45-degree field of view
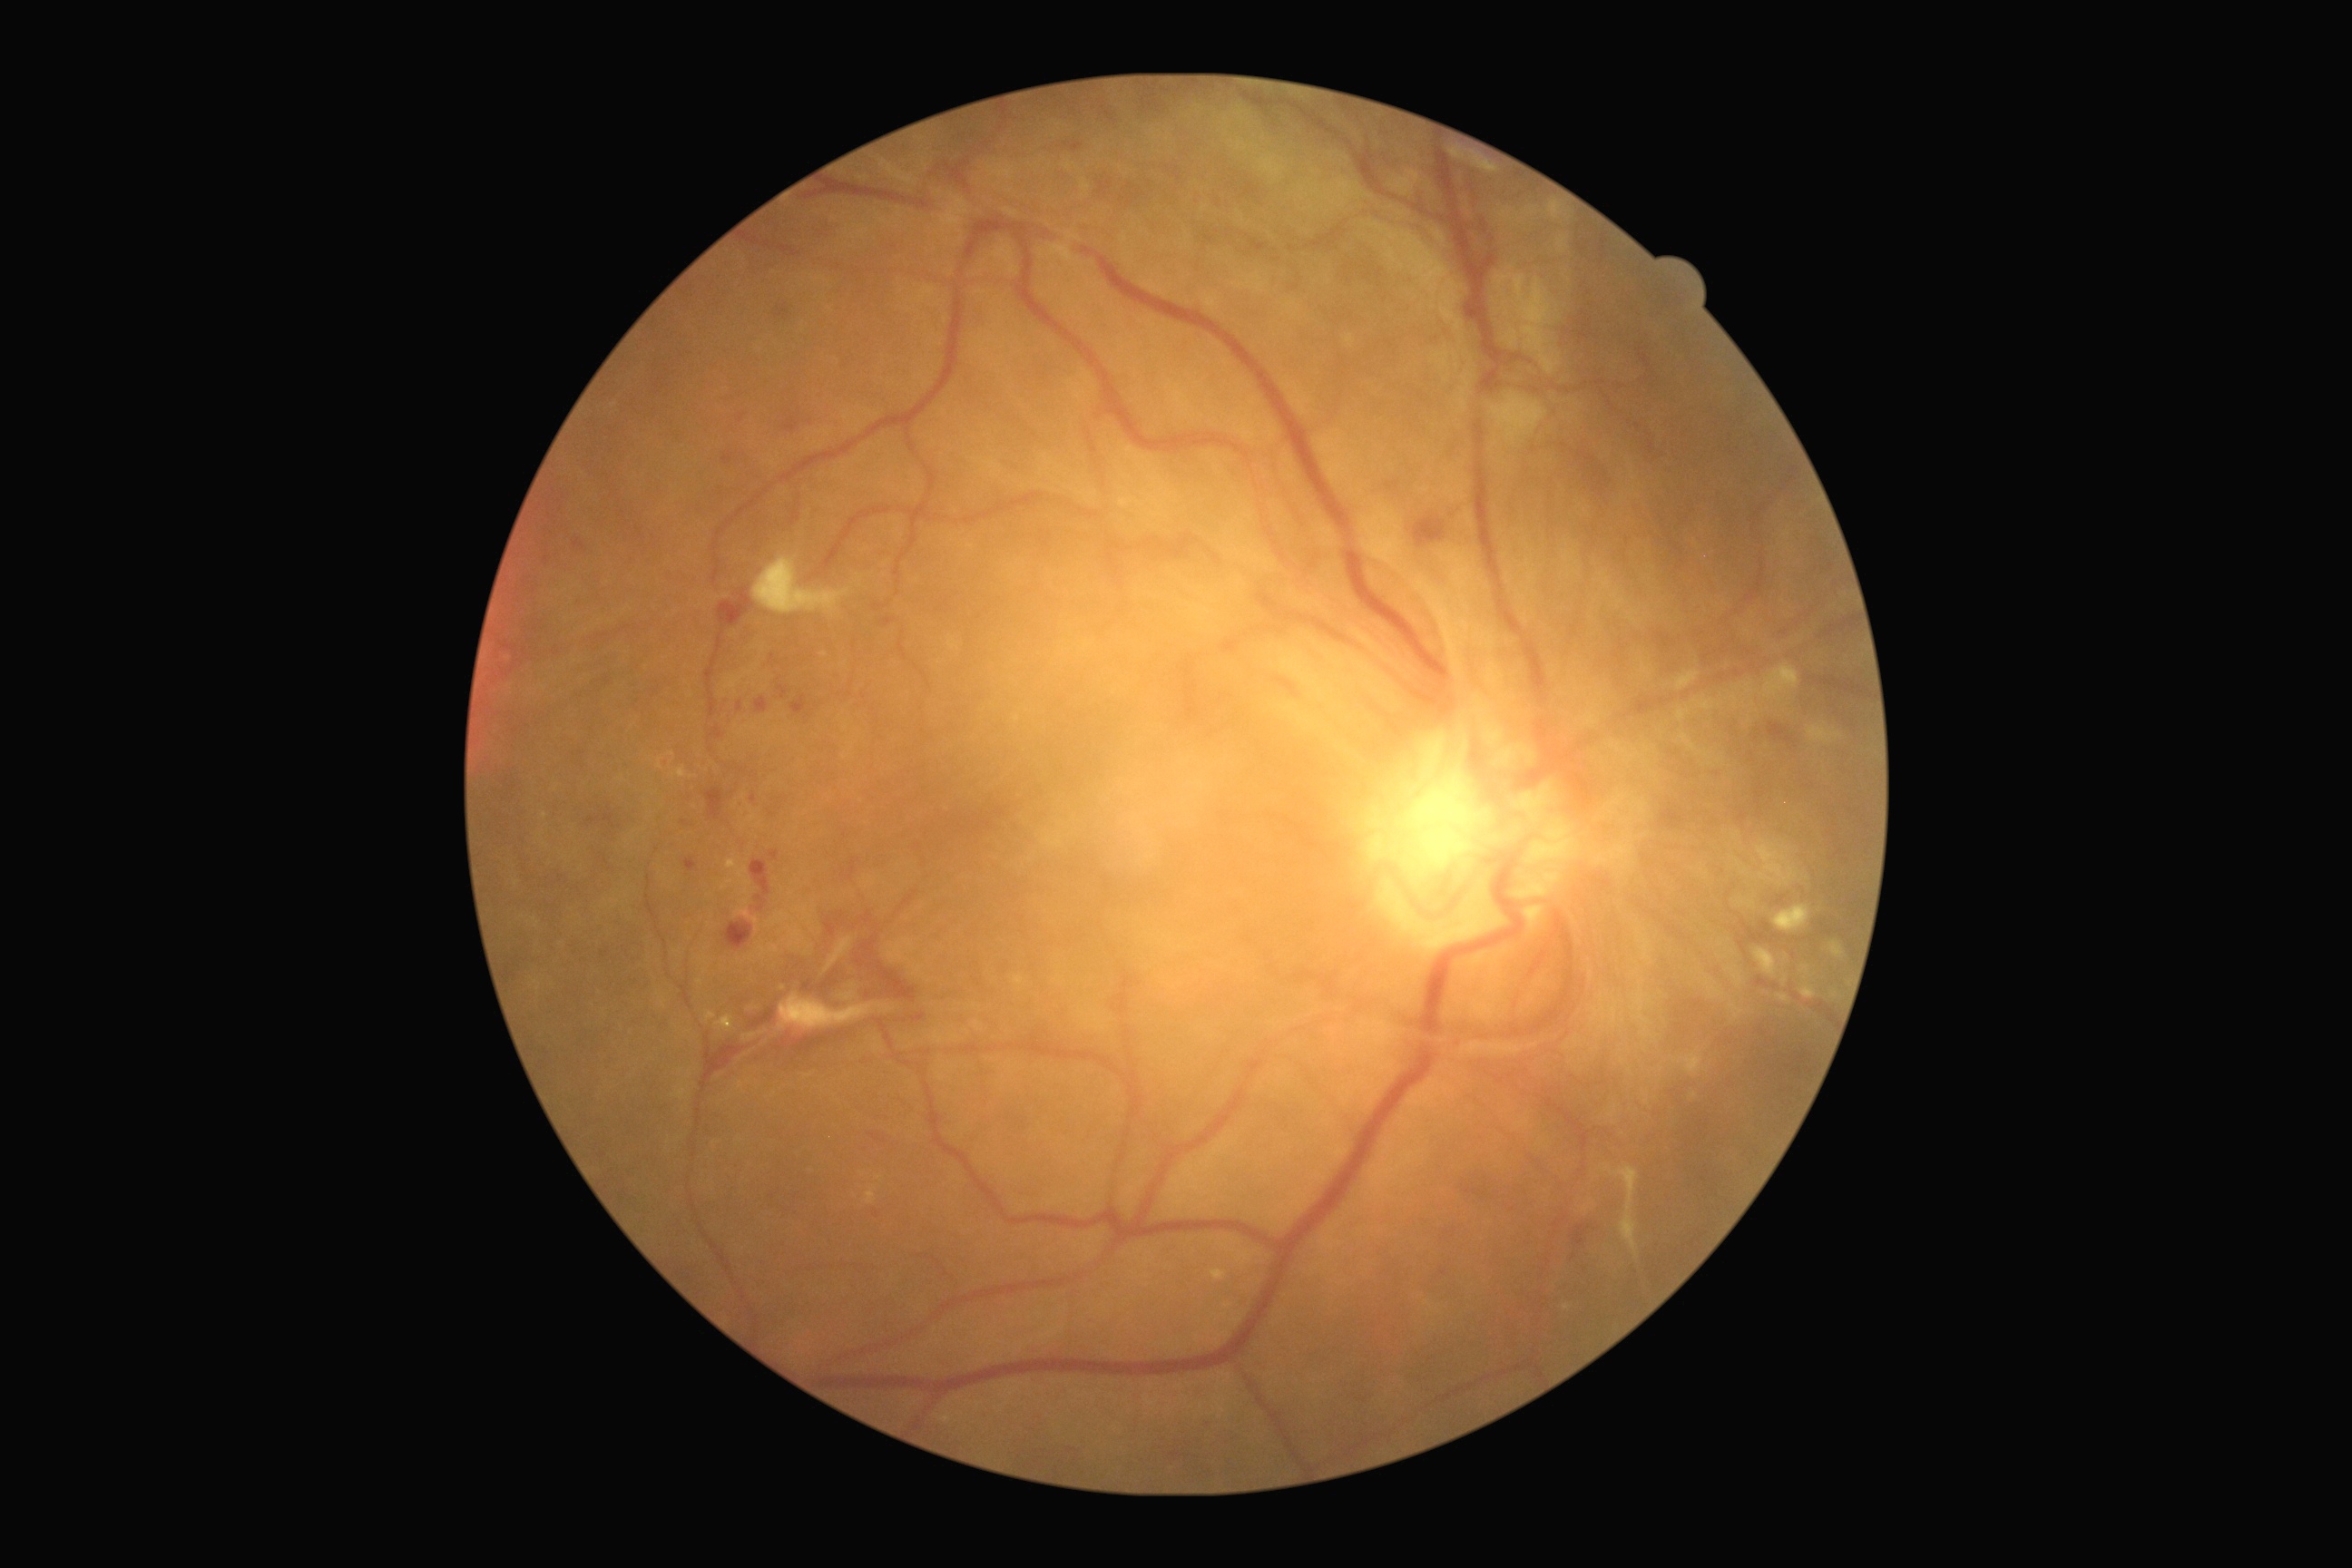
Diabetic retinopathy (DR): 4/4 — neovascularization and/or vitreous/pre-retinal hemorrhage.